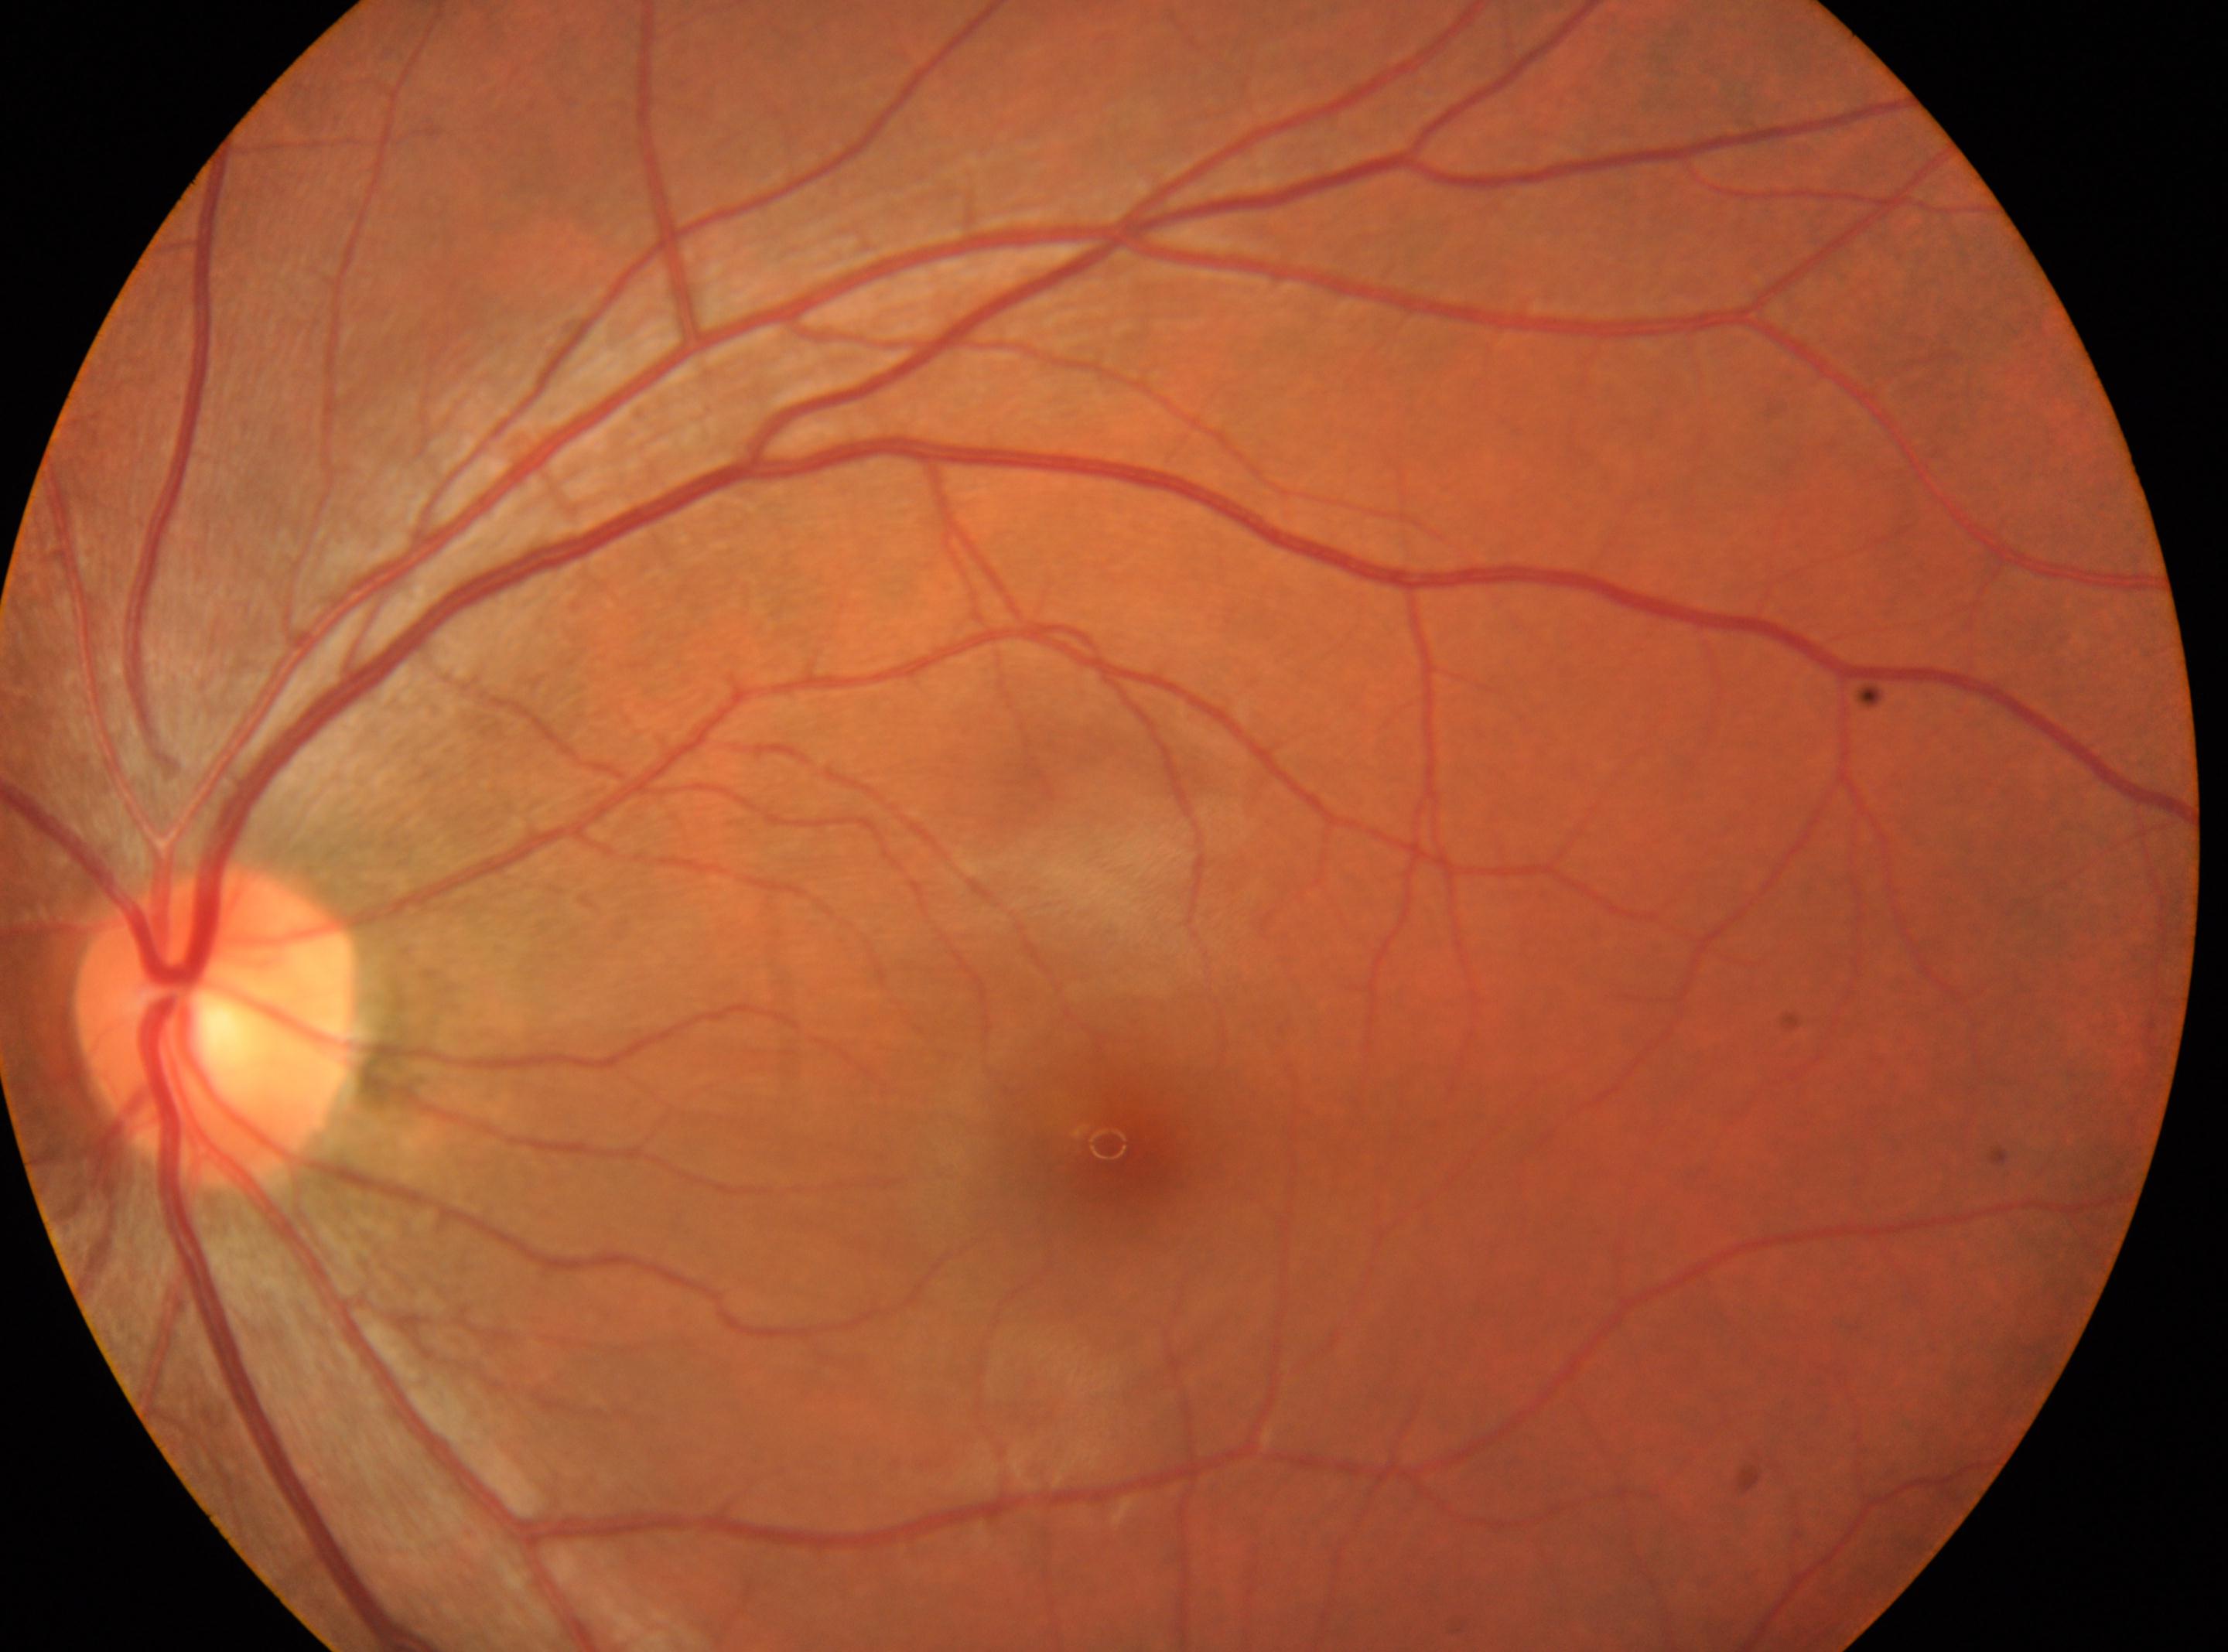

Eye: OS.
DR stage is grade 0.
Fovea center: (x=1123, y=1159).
The optic disc center is at (x=214, y=1023).